Color fundus image; posterior pole field covering the optic disc and macula; FOV: 50 degrees.
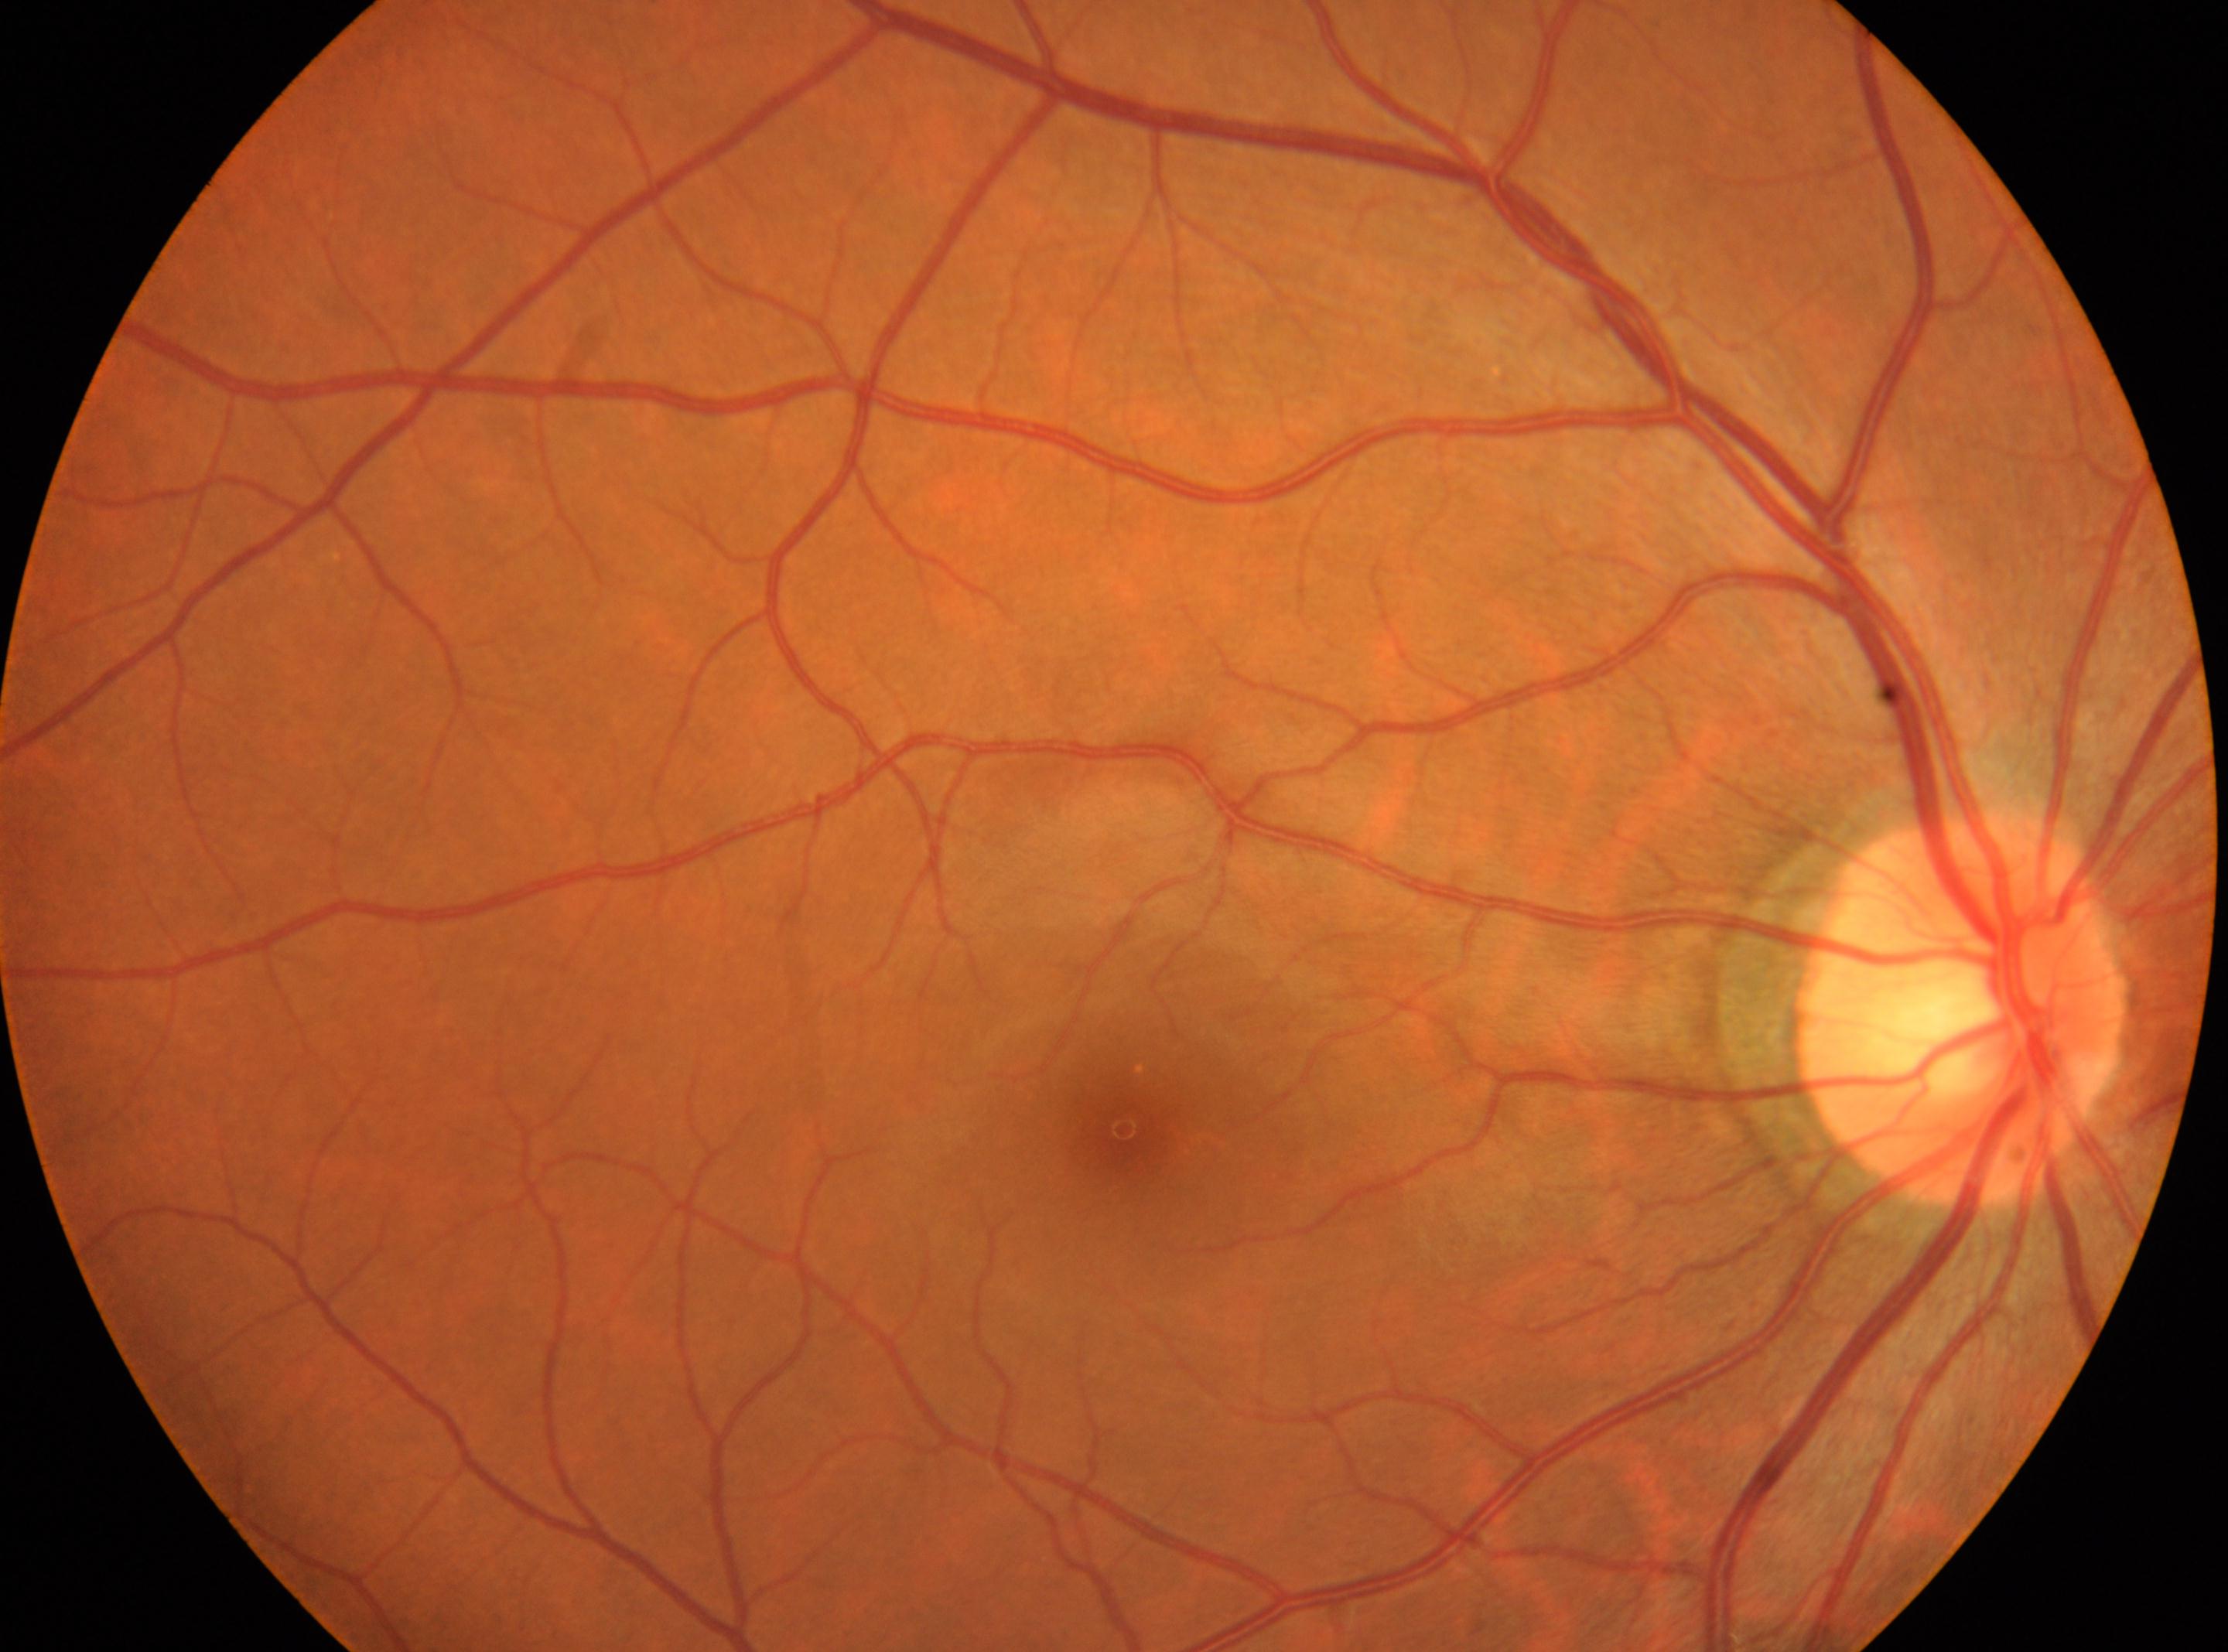

diabetic retinopathy (DR): grade 0; macula center: x=1123, y=1128; laterality: oculus dexter; ONH: x=1960, y=1007.